FOV: 45 degrees:
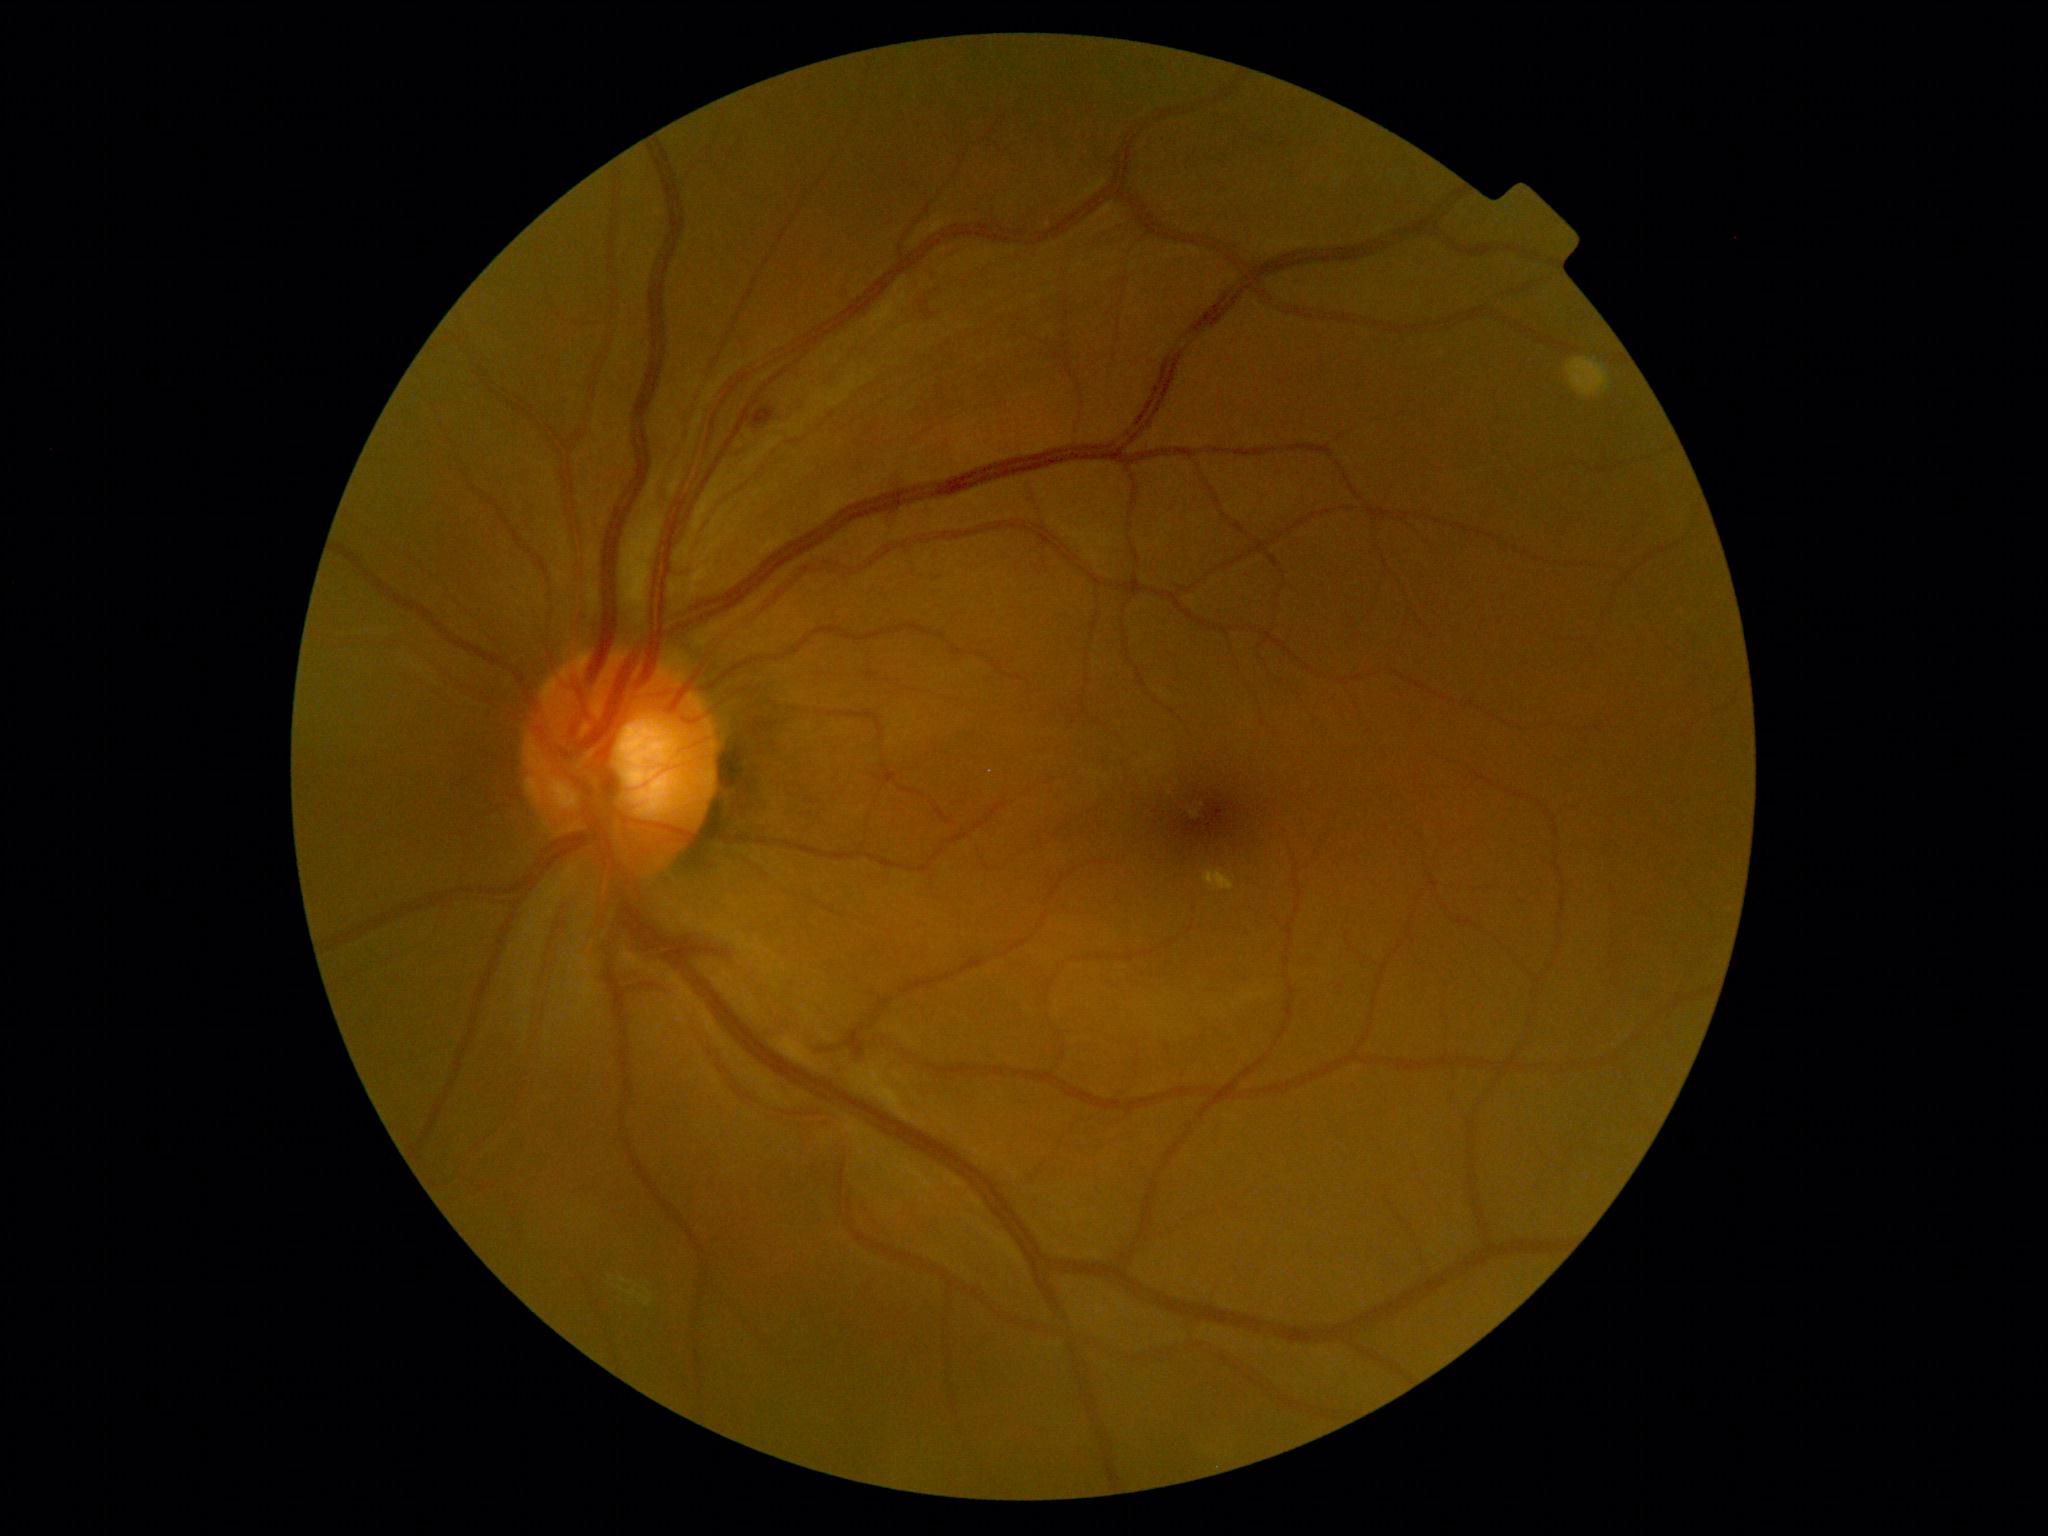
Diabetic retinopathy severity is 2 — more than just microaneurysms but less than severe NPDR.